Non-mydriatic acquisition · image size 240x240:
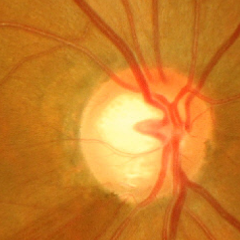 Fundus image with findings of advanced glaucomatous optic neuropathy.